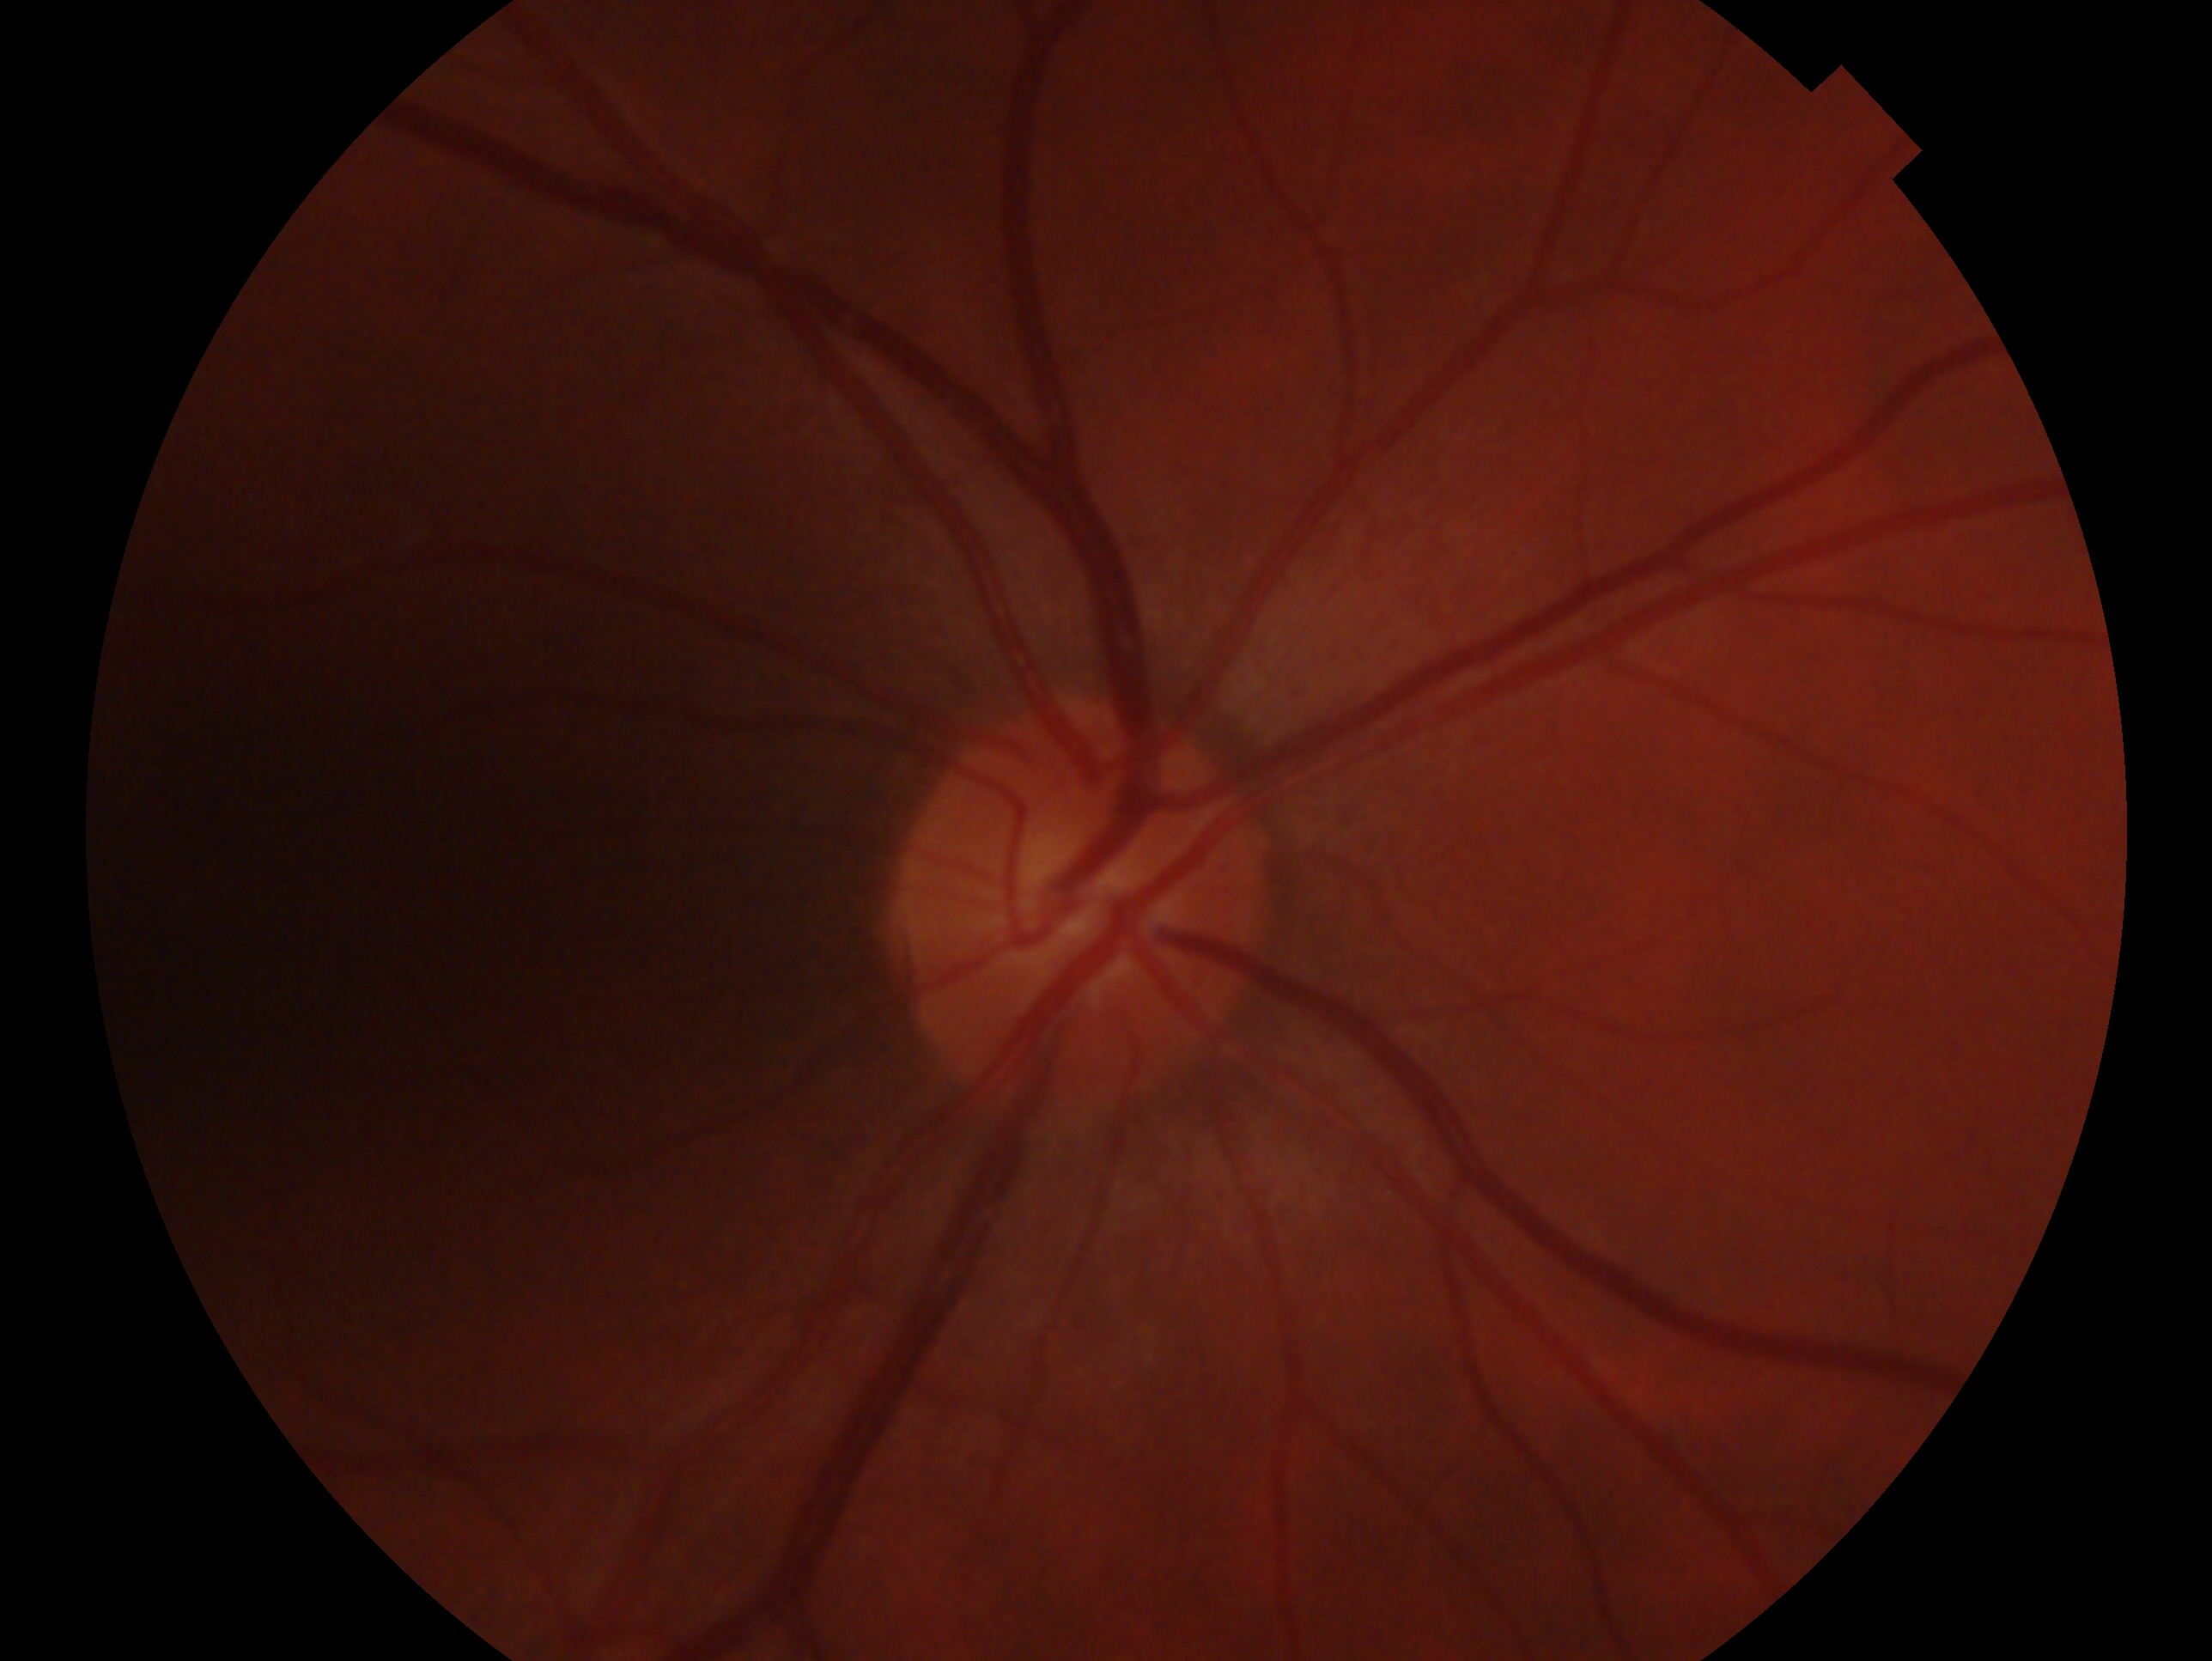

Q: What is the laterality?
A: OD
Q: What is the glaucoma diagnosis?
A: negative for glaucoma